Davis DR grading. Color fundus photograph. Acquired with a NIDEK AFC-230. No pharmacologic dilation.
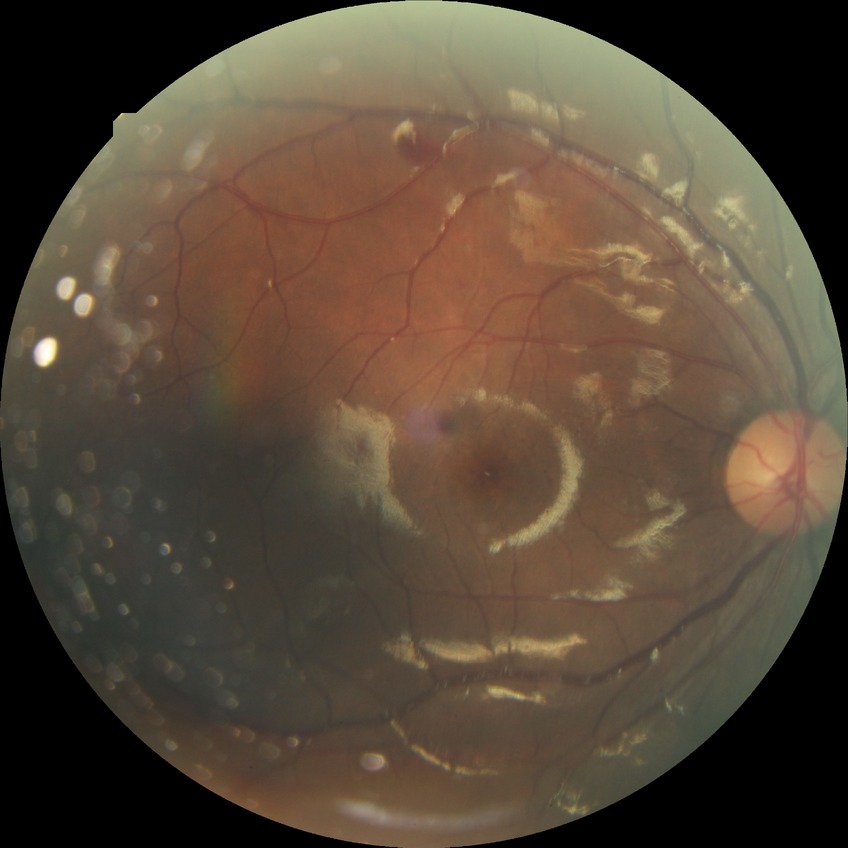

Disease class: non-proliferative diabetic retinopathy. Diabetic retinopathy (DR) is SDR (simple diabetic retinopathy).